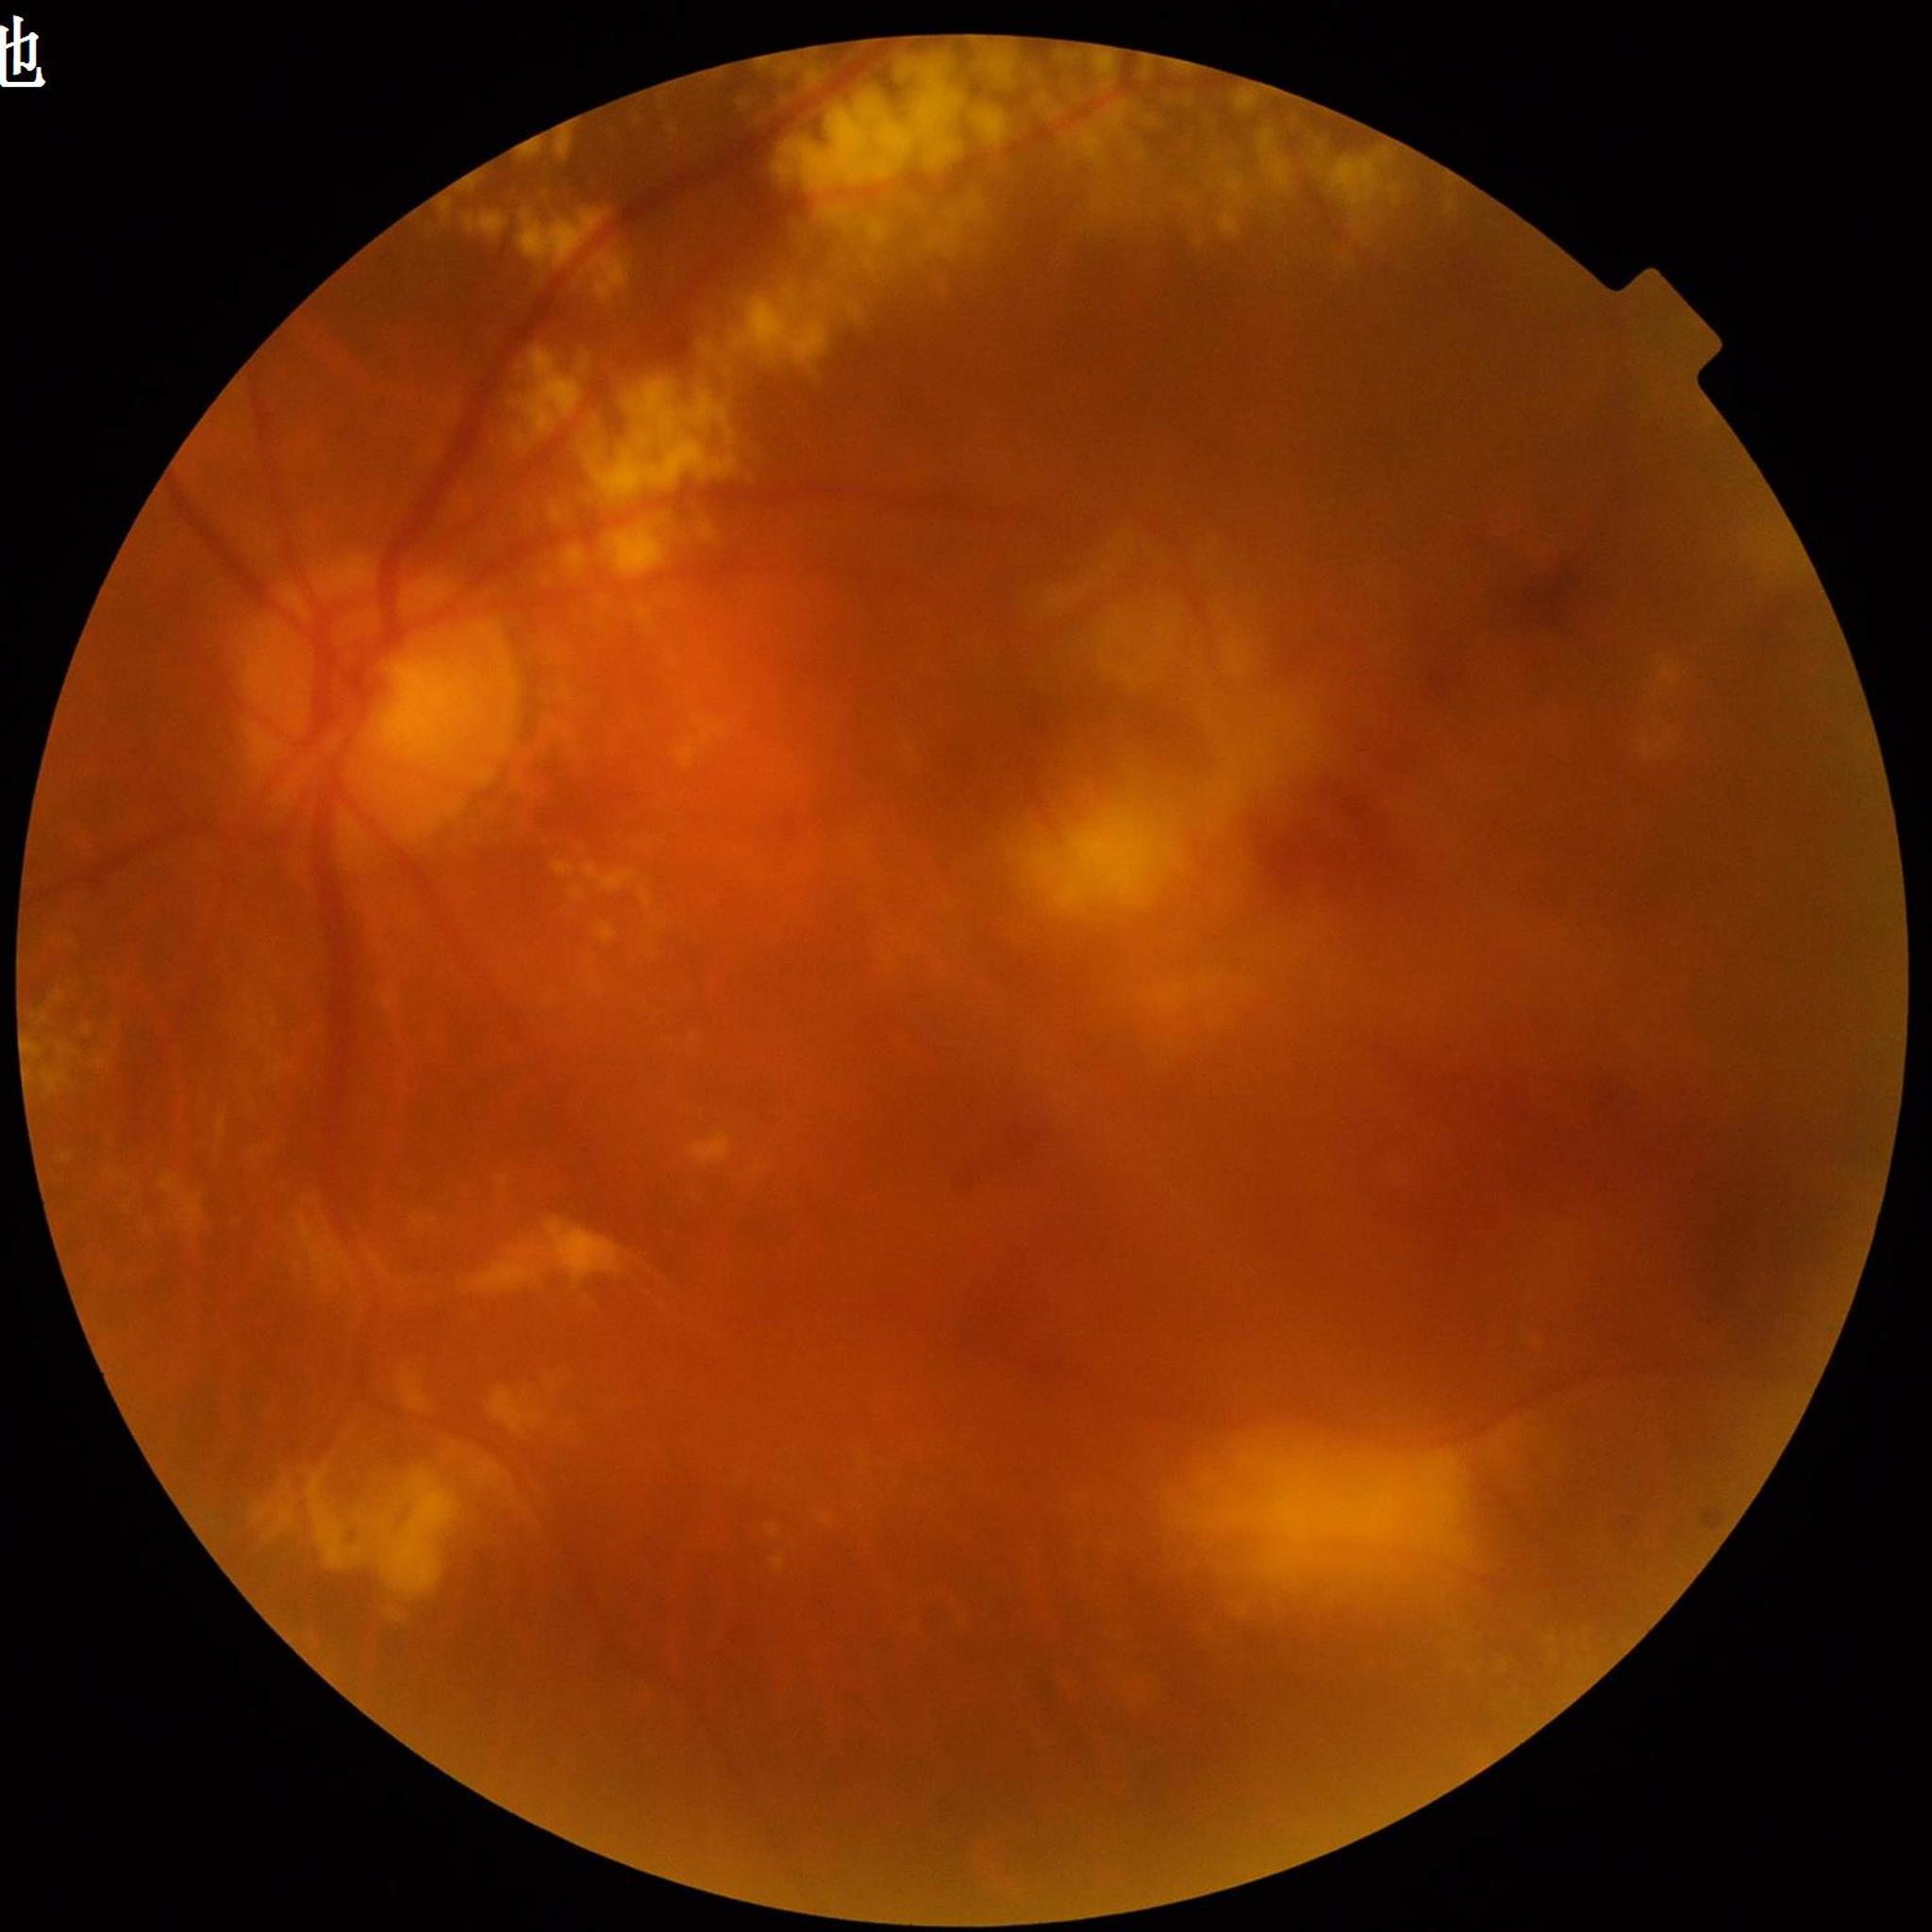

Disease class: diabetic retinopathy; Quality assessment: concerns include blur.